2352 by 1568 pixels: 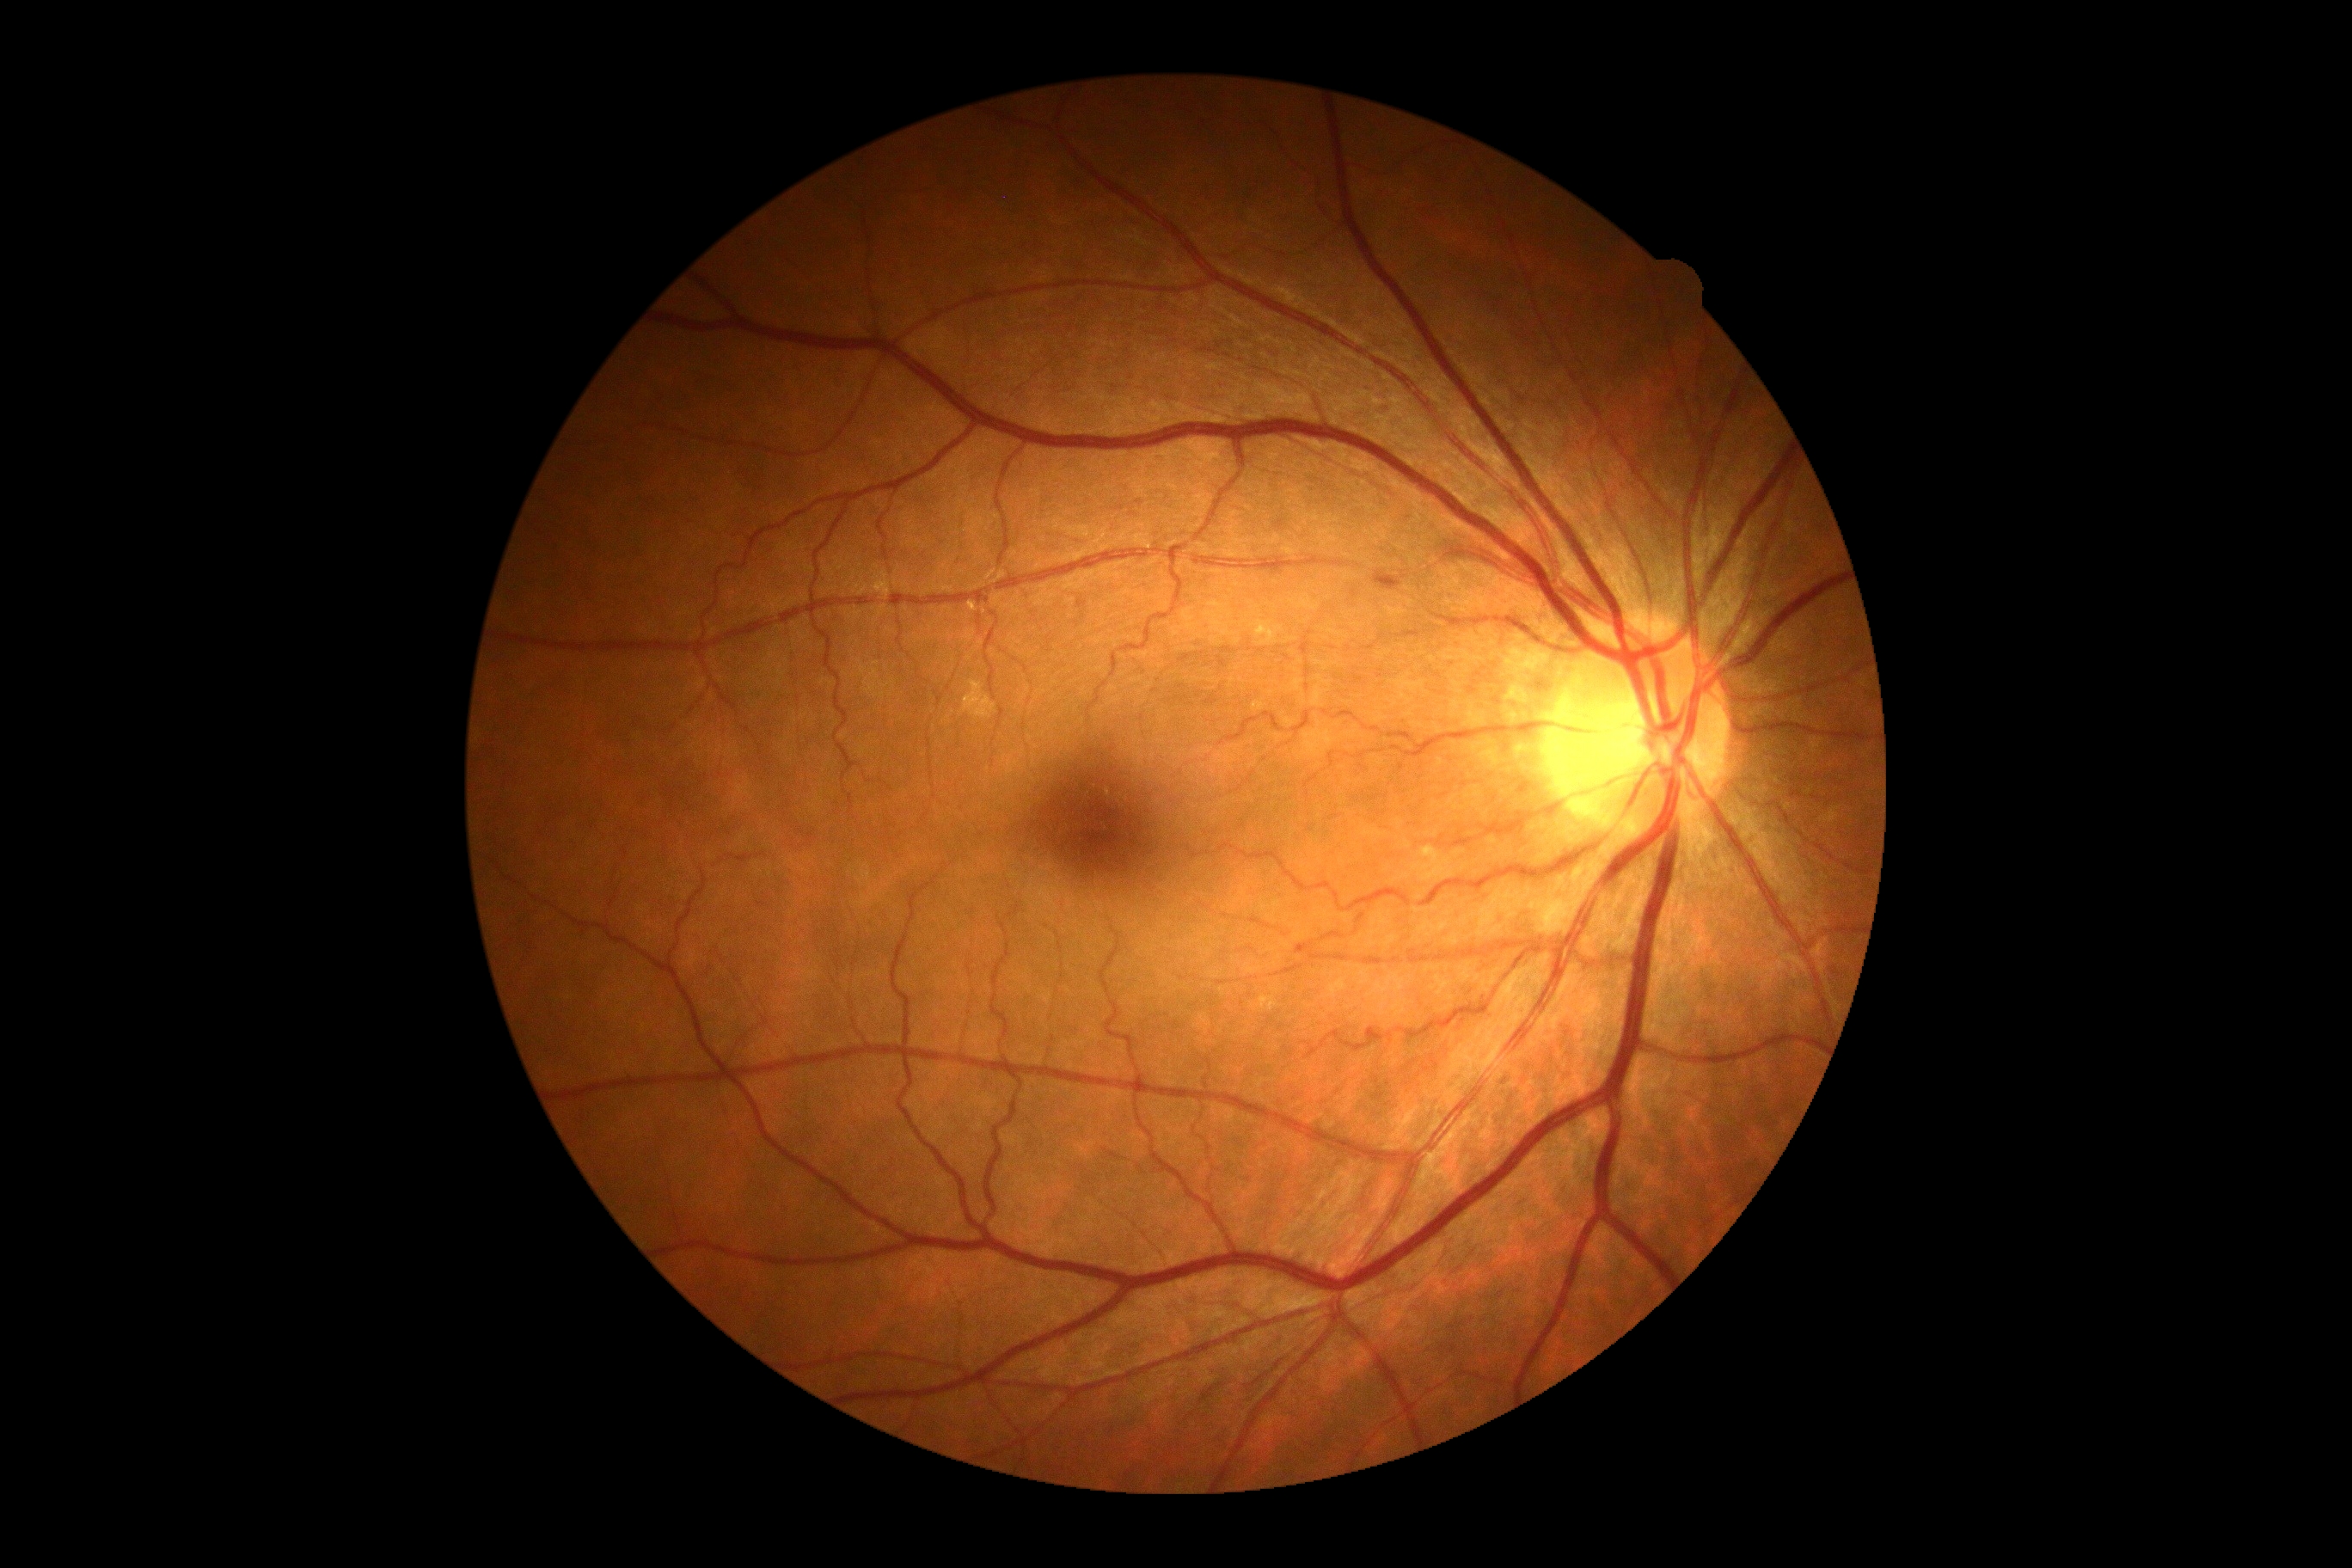

DR grade: 0.